45° field of view:
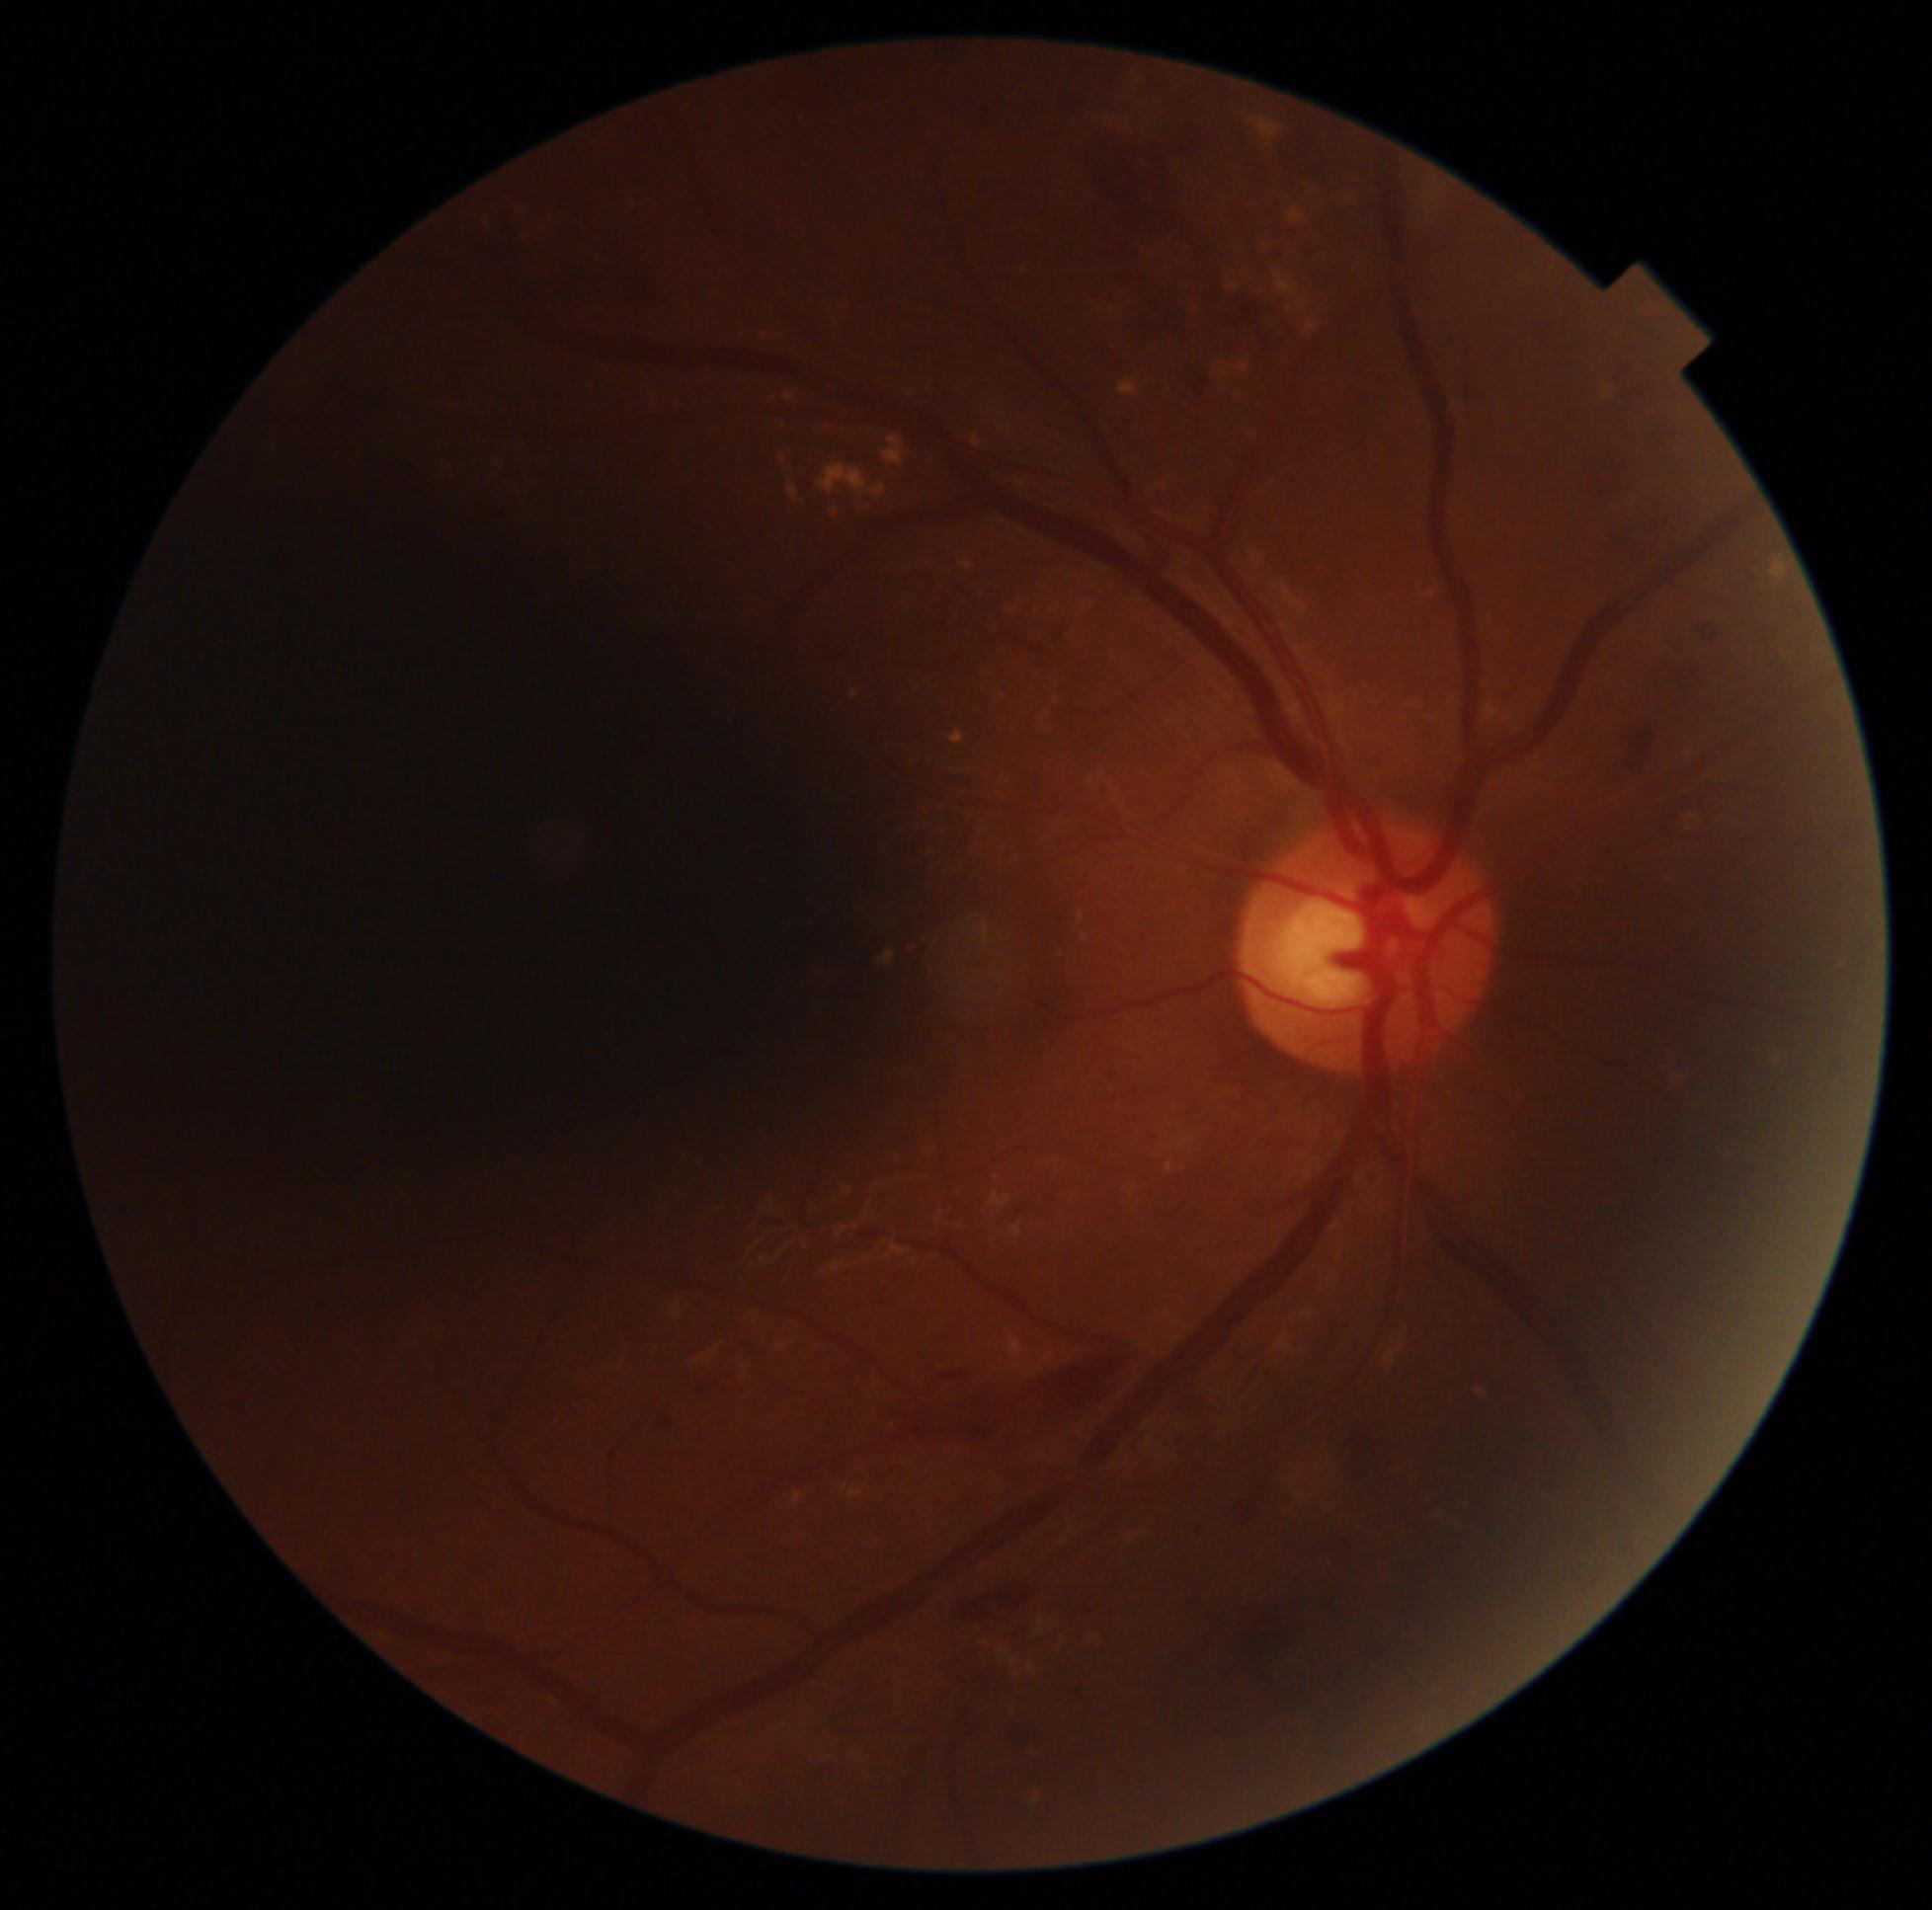

DR stage: grade 2 (moderate NPDR). Disease class: non-proliferative diabetic retinopathy.